FOV: 45 degrees
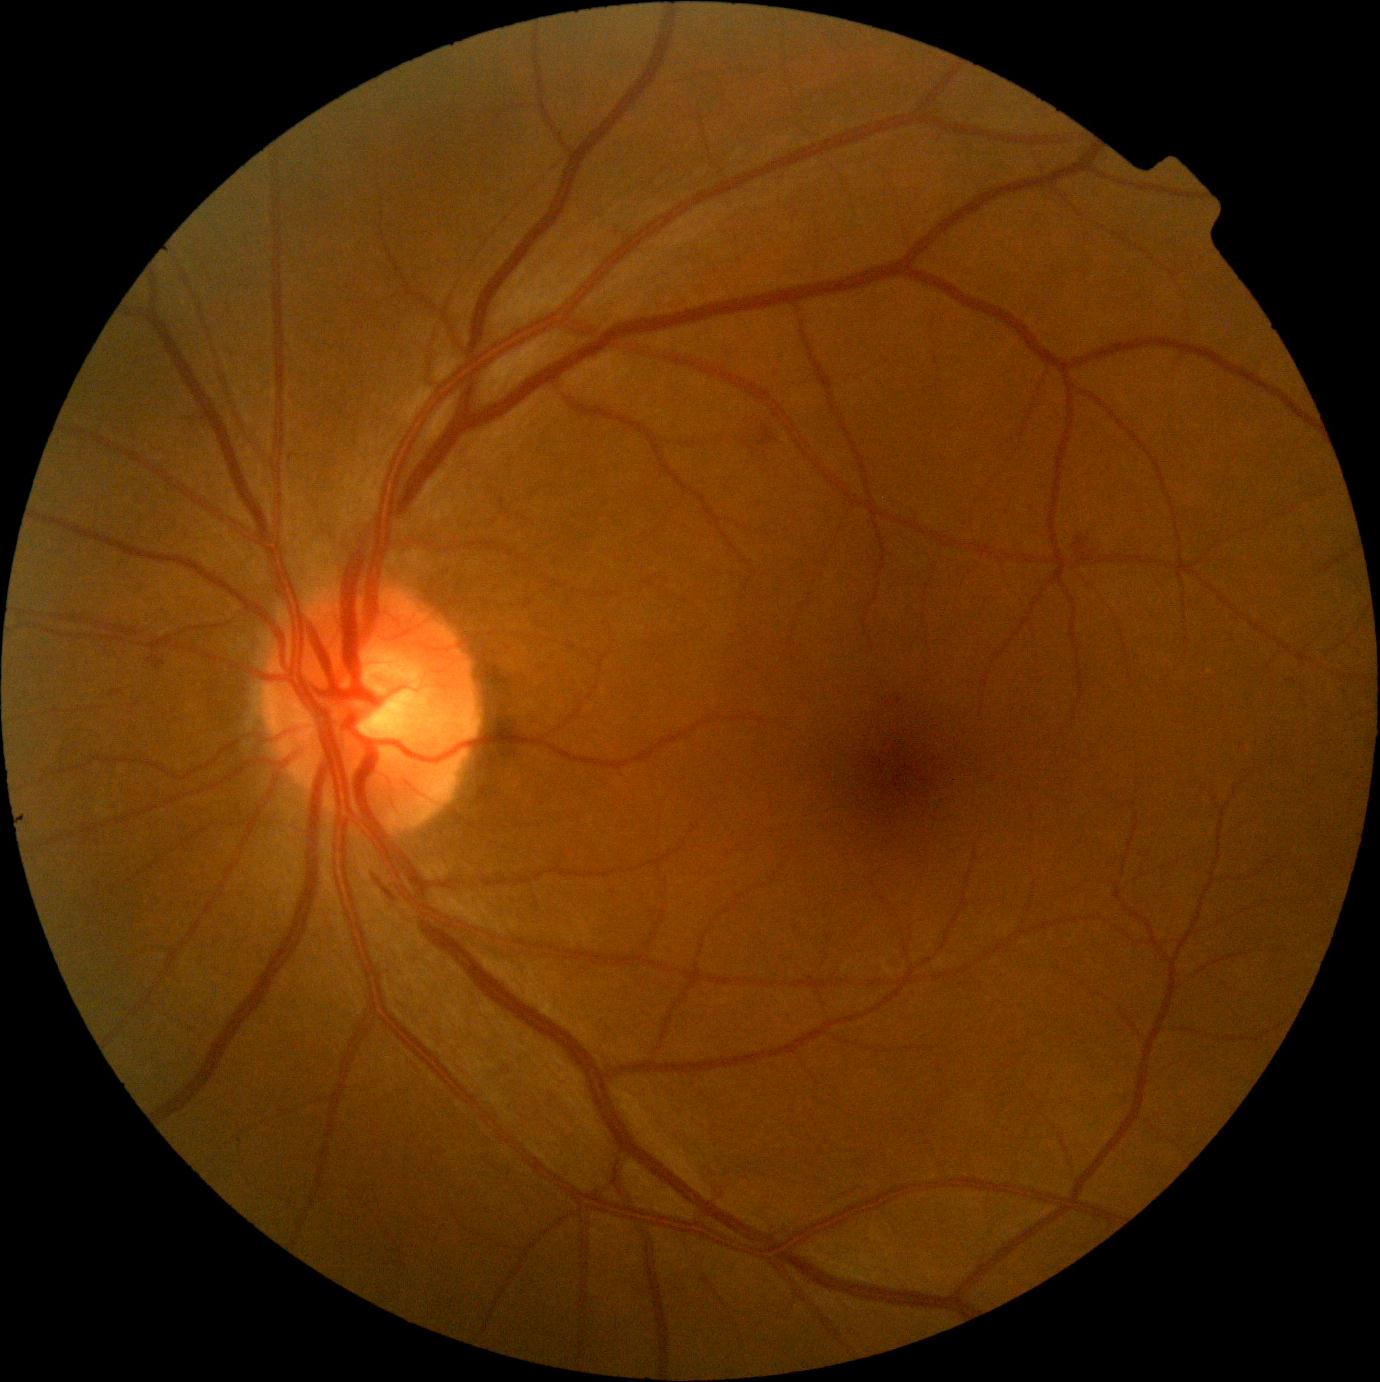 {"dr_grade": "moderate non-proliferative diabetic retinopathy (2) — more than just microaneurysms but less than severe NPDR", "dr_category": "non-proliferative diabetic retinopathy"}